Captured with the Clarity RetCam 3 (130° field of view); wide-field contact fundus photograph of an infant:
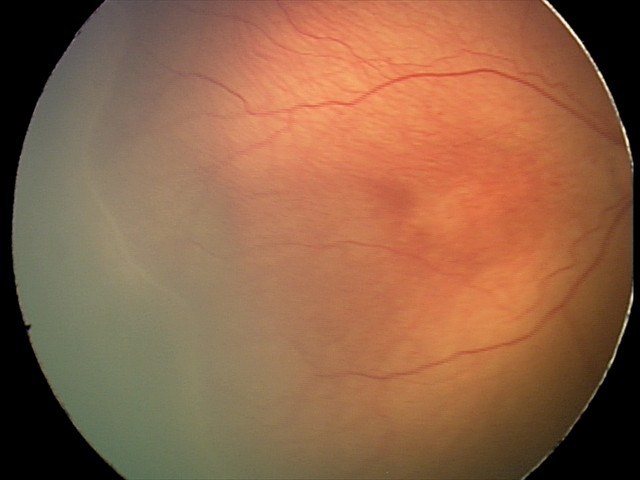

Screening examination consistent with ROP stage 2 — ridge with height and width at the demarcation line. No plus disease.